1440 by 1080 pixels. Camera: Natus RetCam Envision (130° FOV). Infant wide-field retinal image — 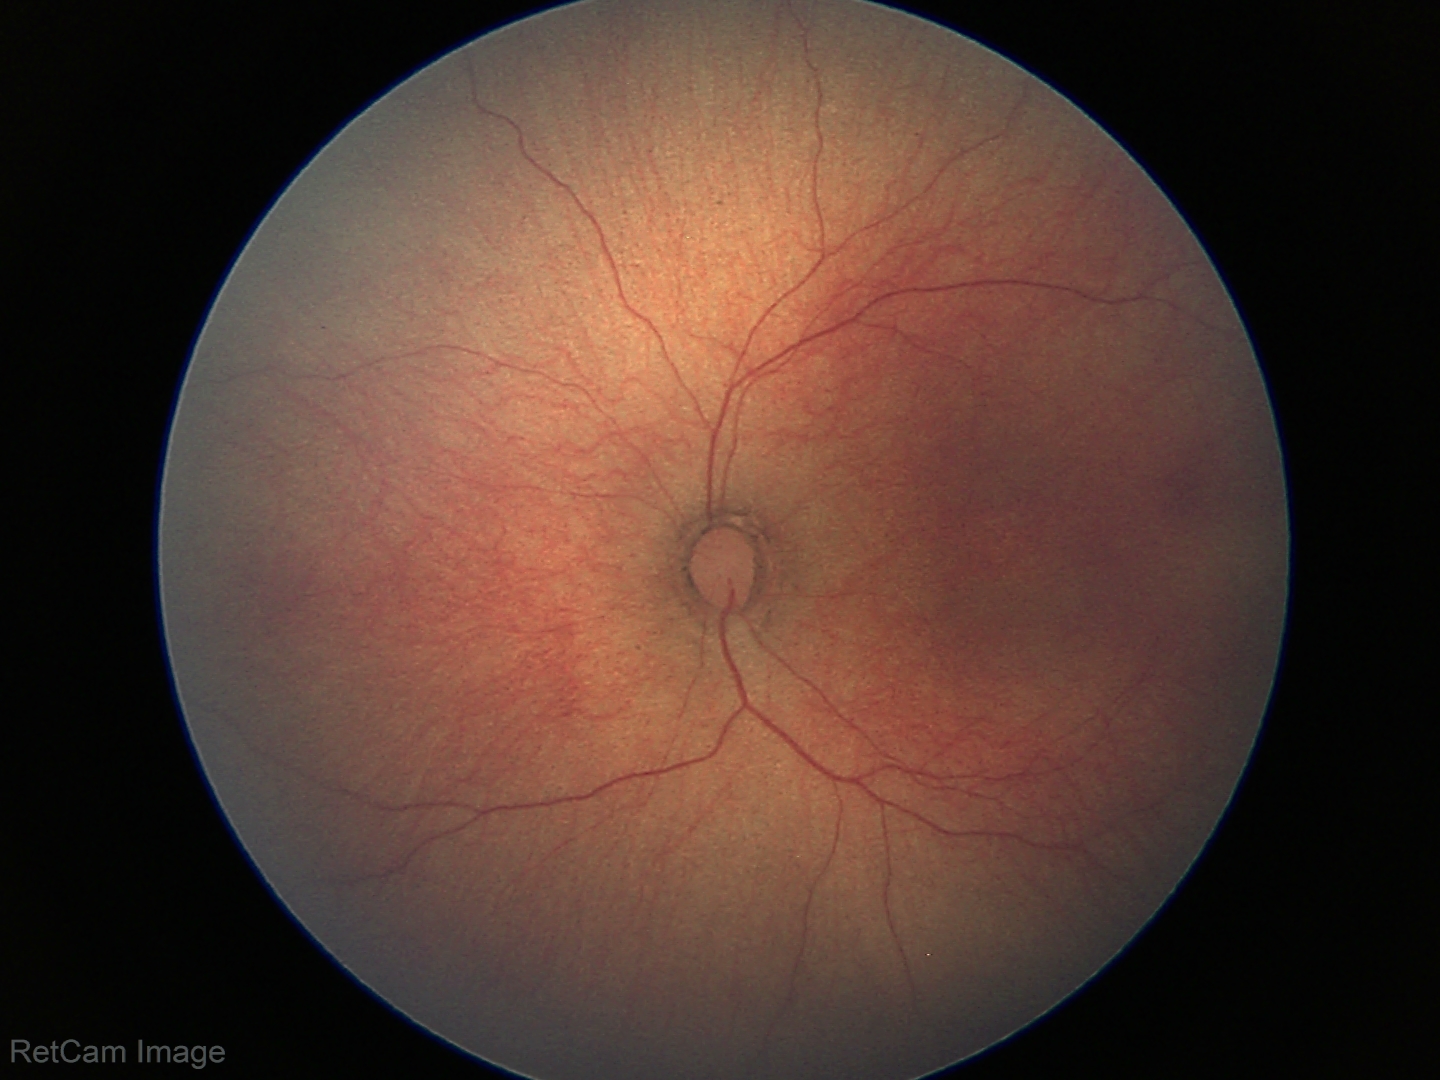 Q: What is the diagnosis from this examination?
A: normal retinal appearance